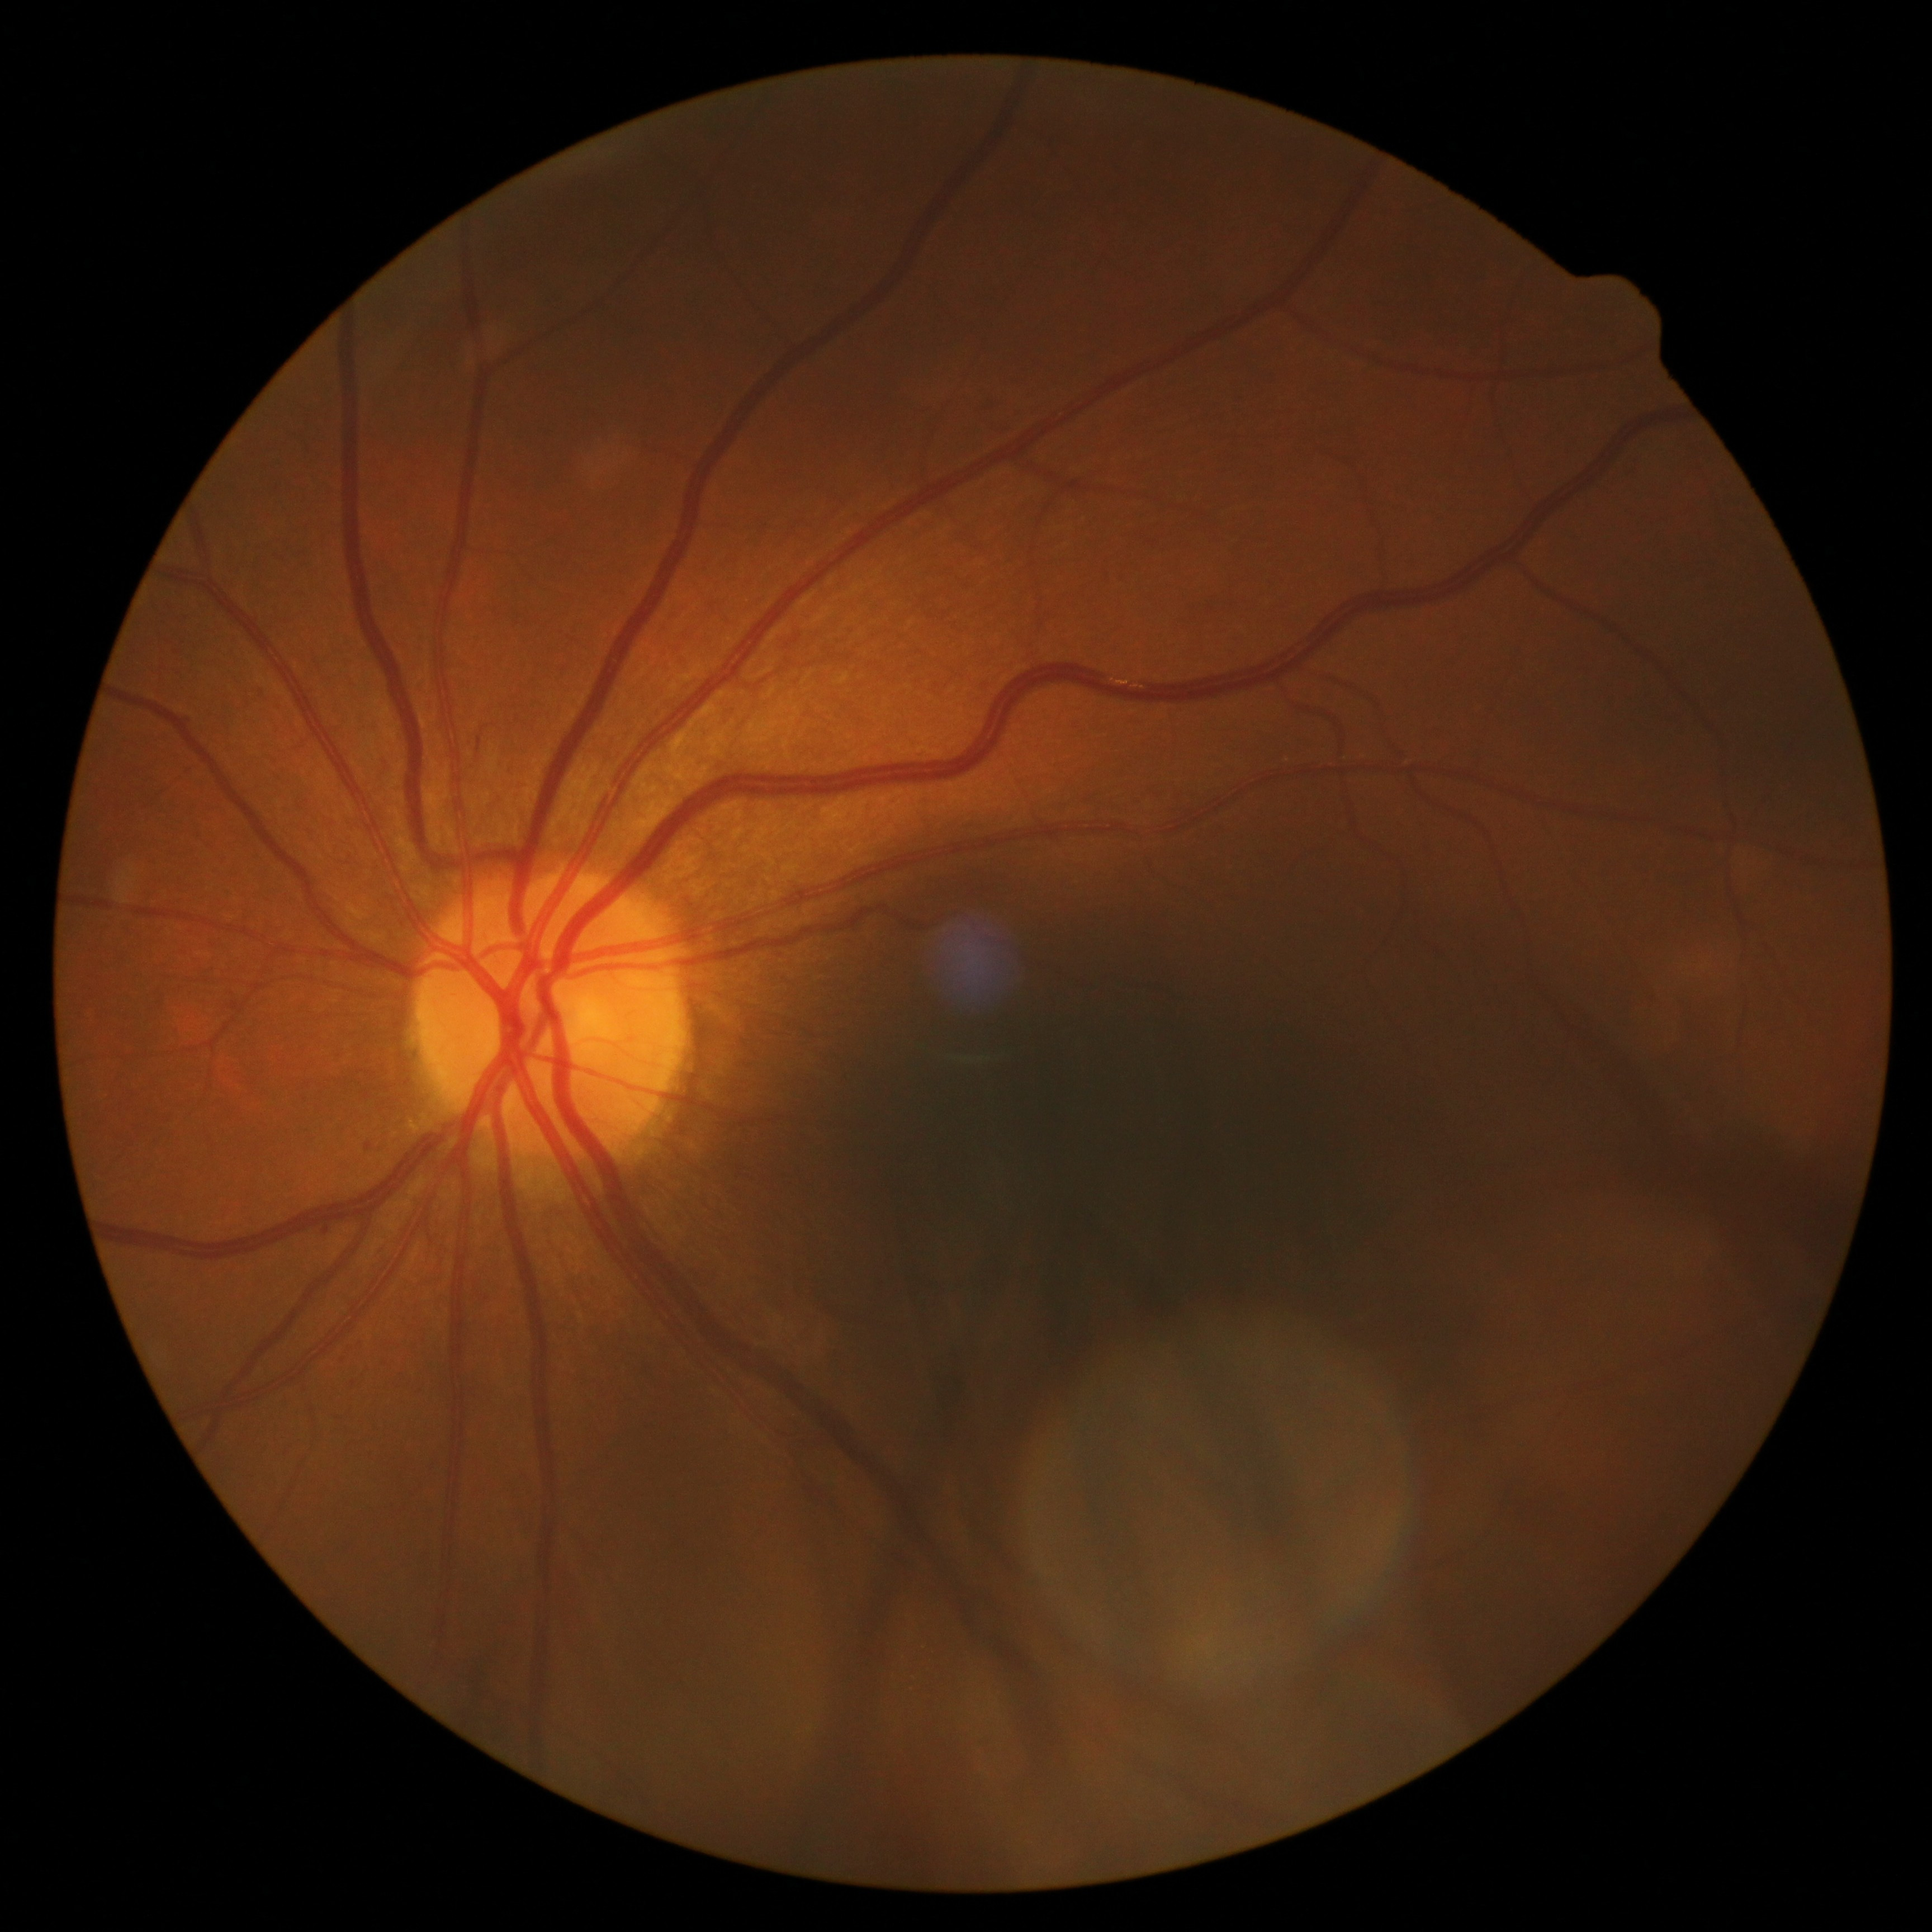

diabetic retinopathy (DR) = 2
DR class = non-proliferative diabetic retinopathy